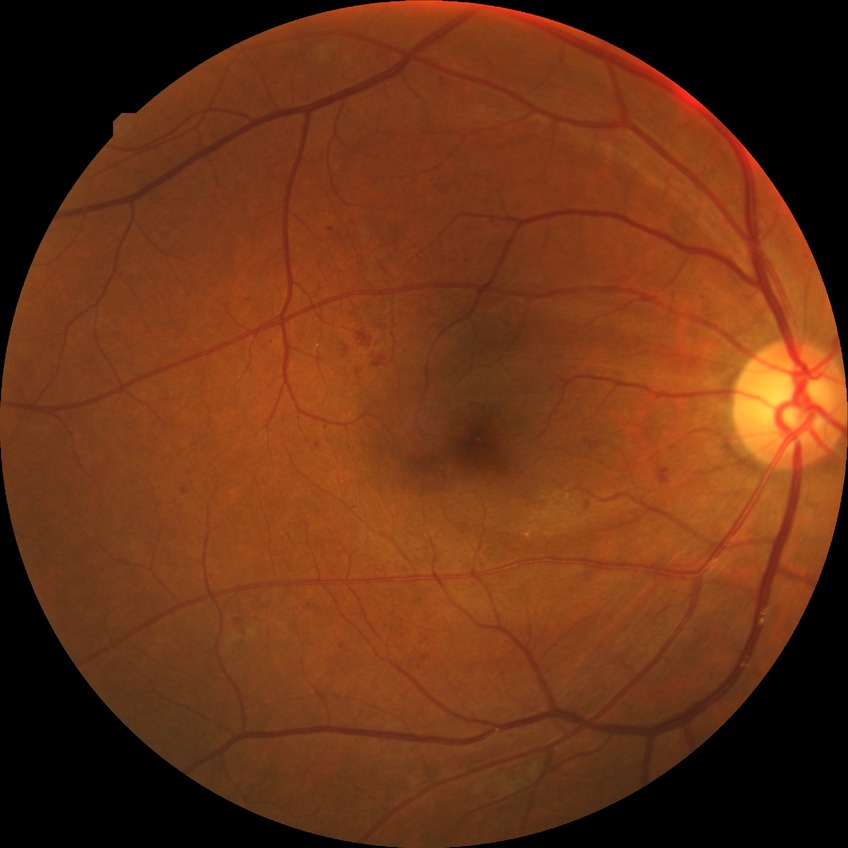 Davis stage = PPDR